Camera: Nidek AFC-330:
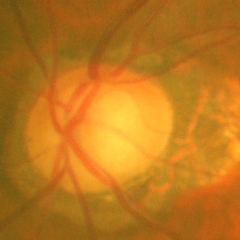
Glaucoma diagnosis = advanced glaucoma.